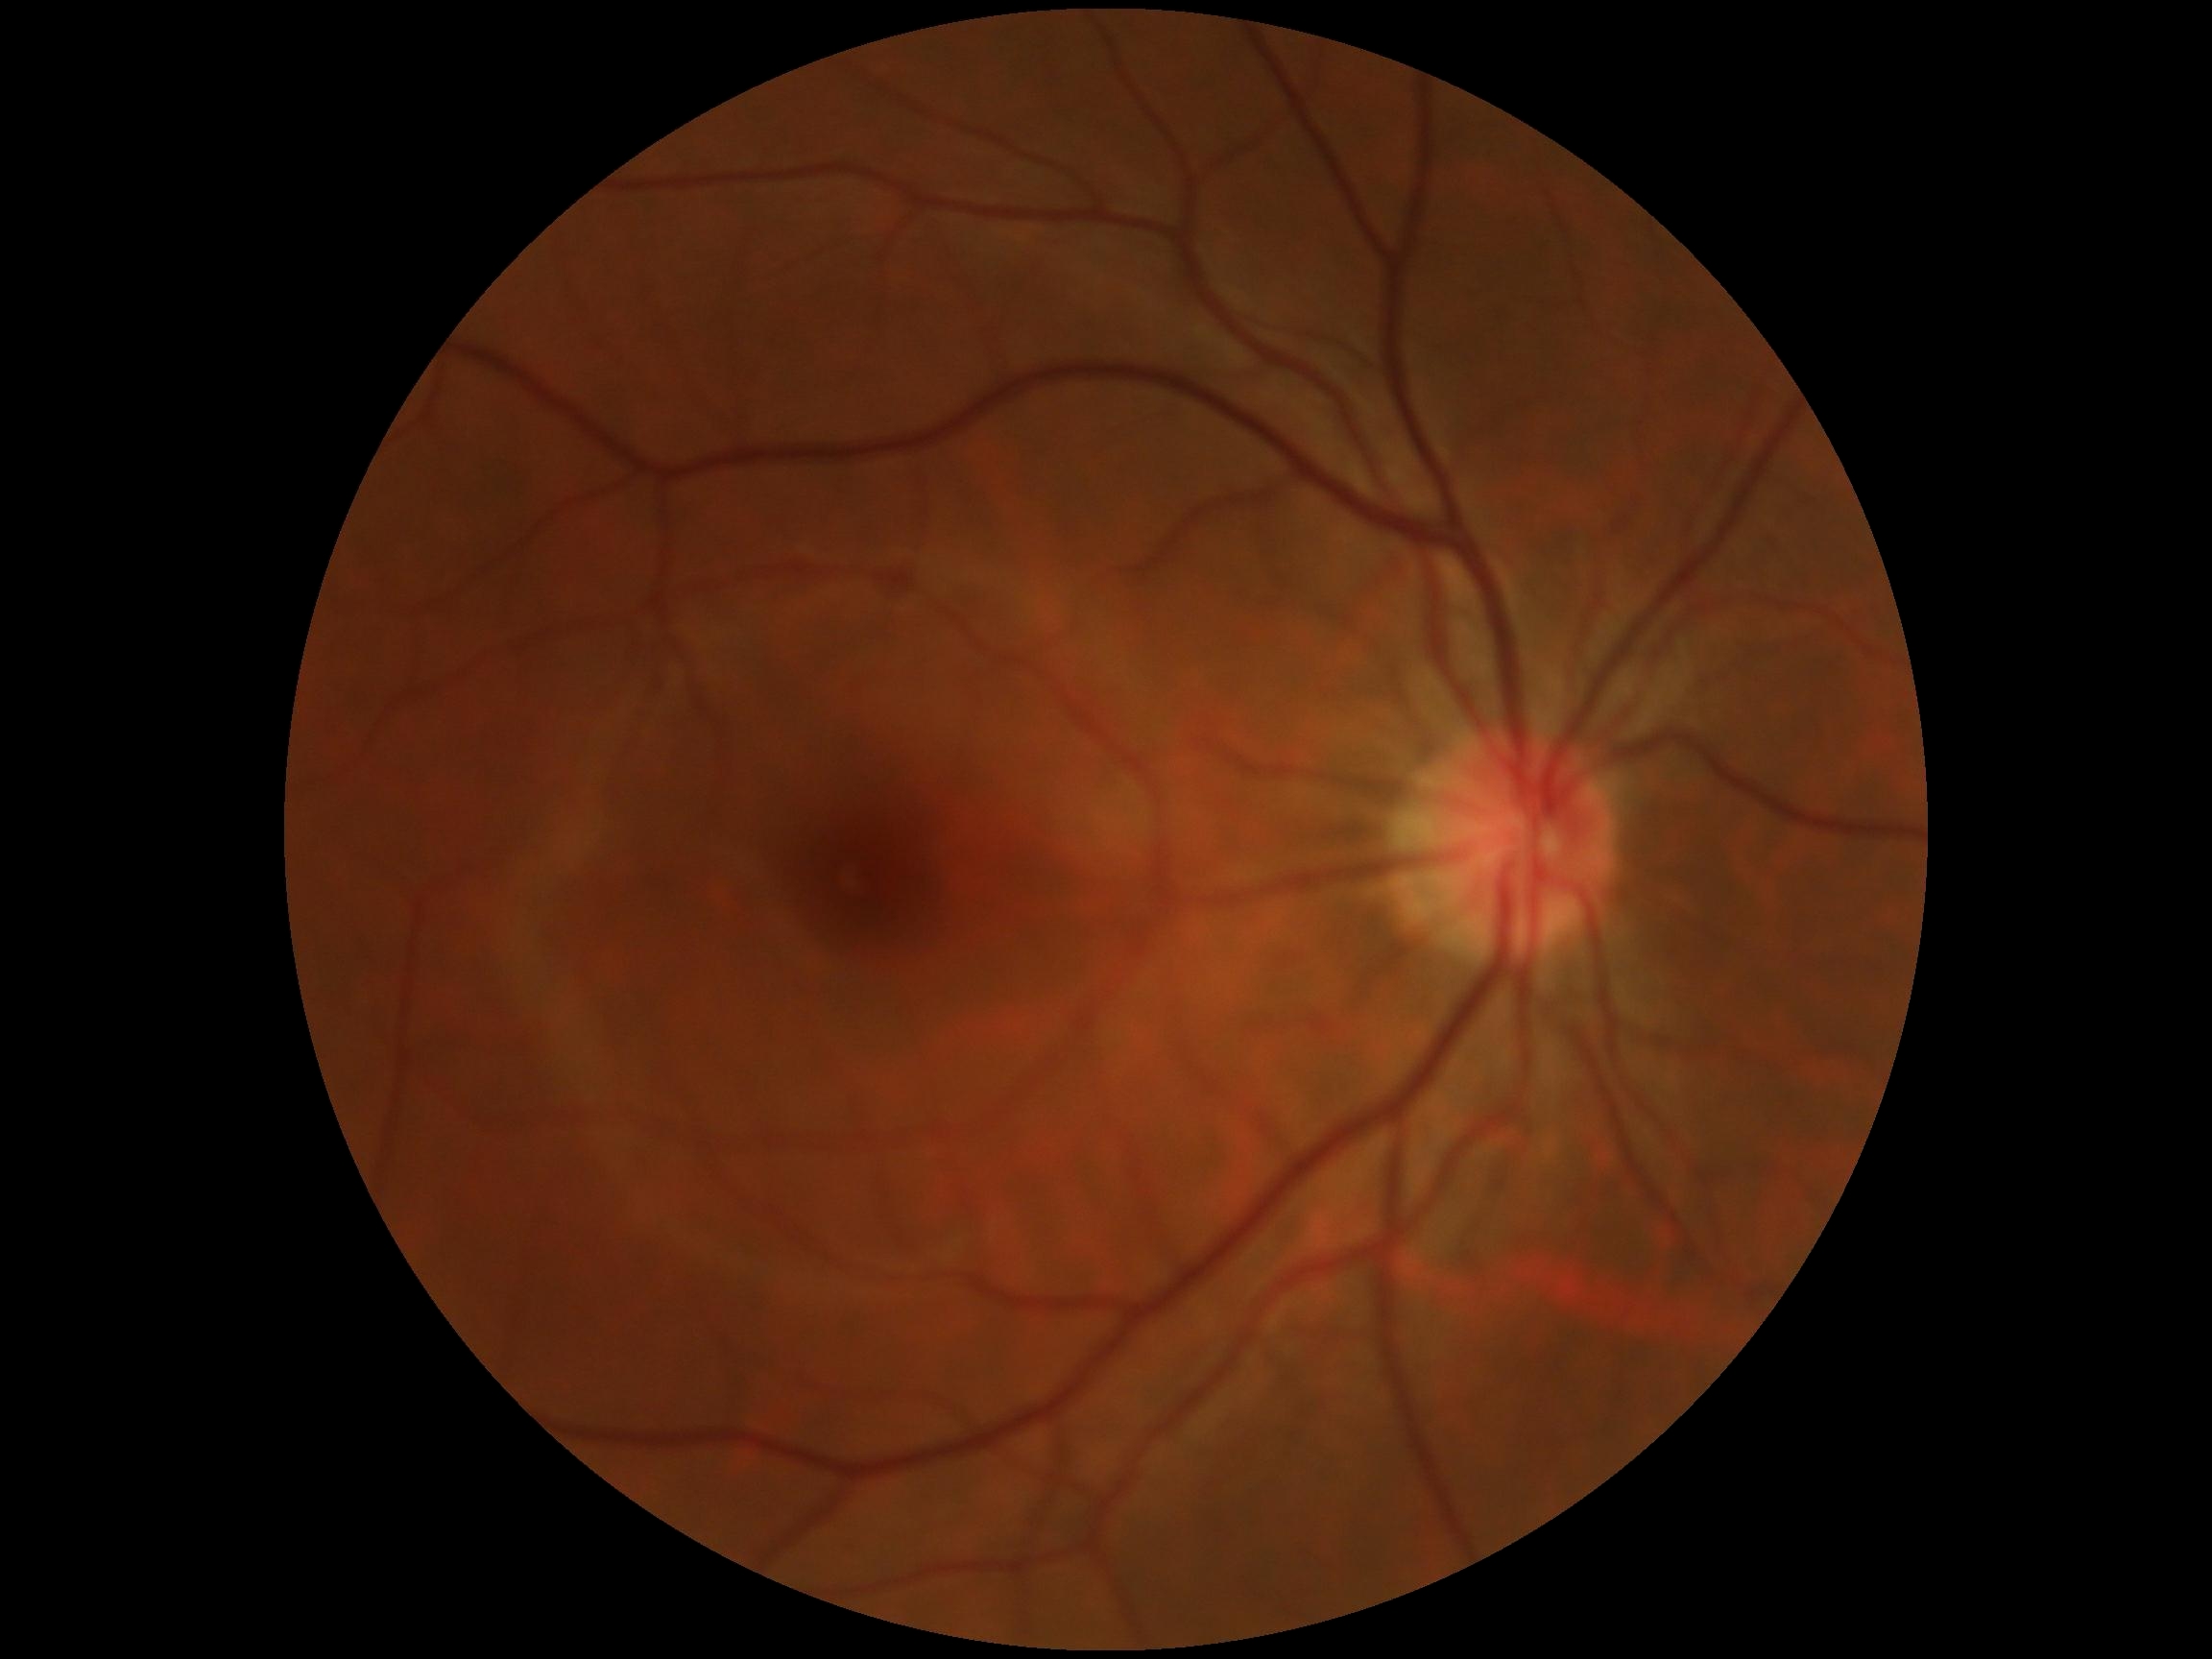

Retinopathy: grade 0 (no apparent retinopathy).